45-degree field of view; 1932 by 1932 pixels: 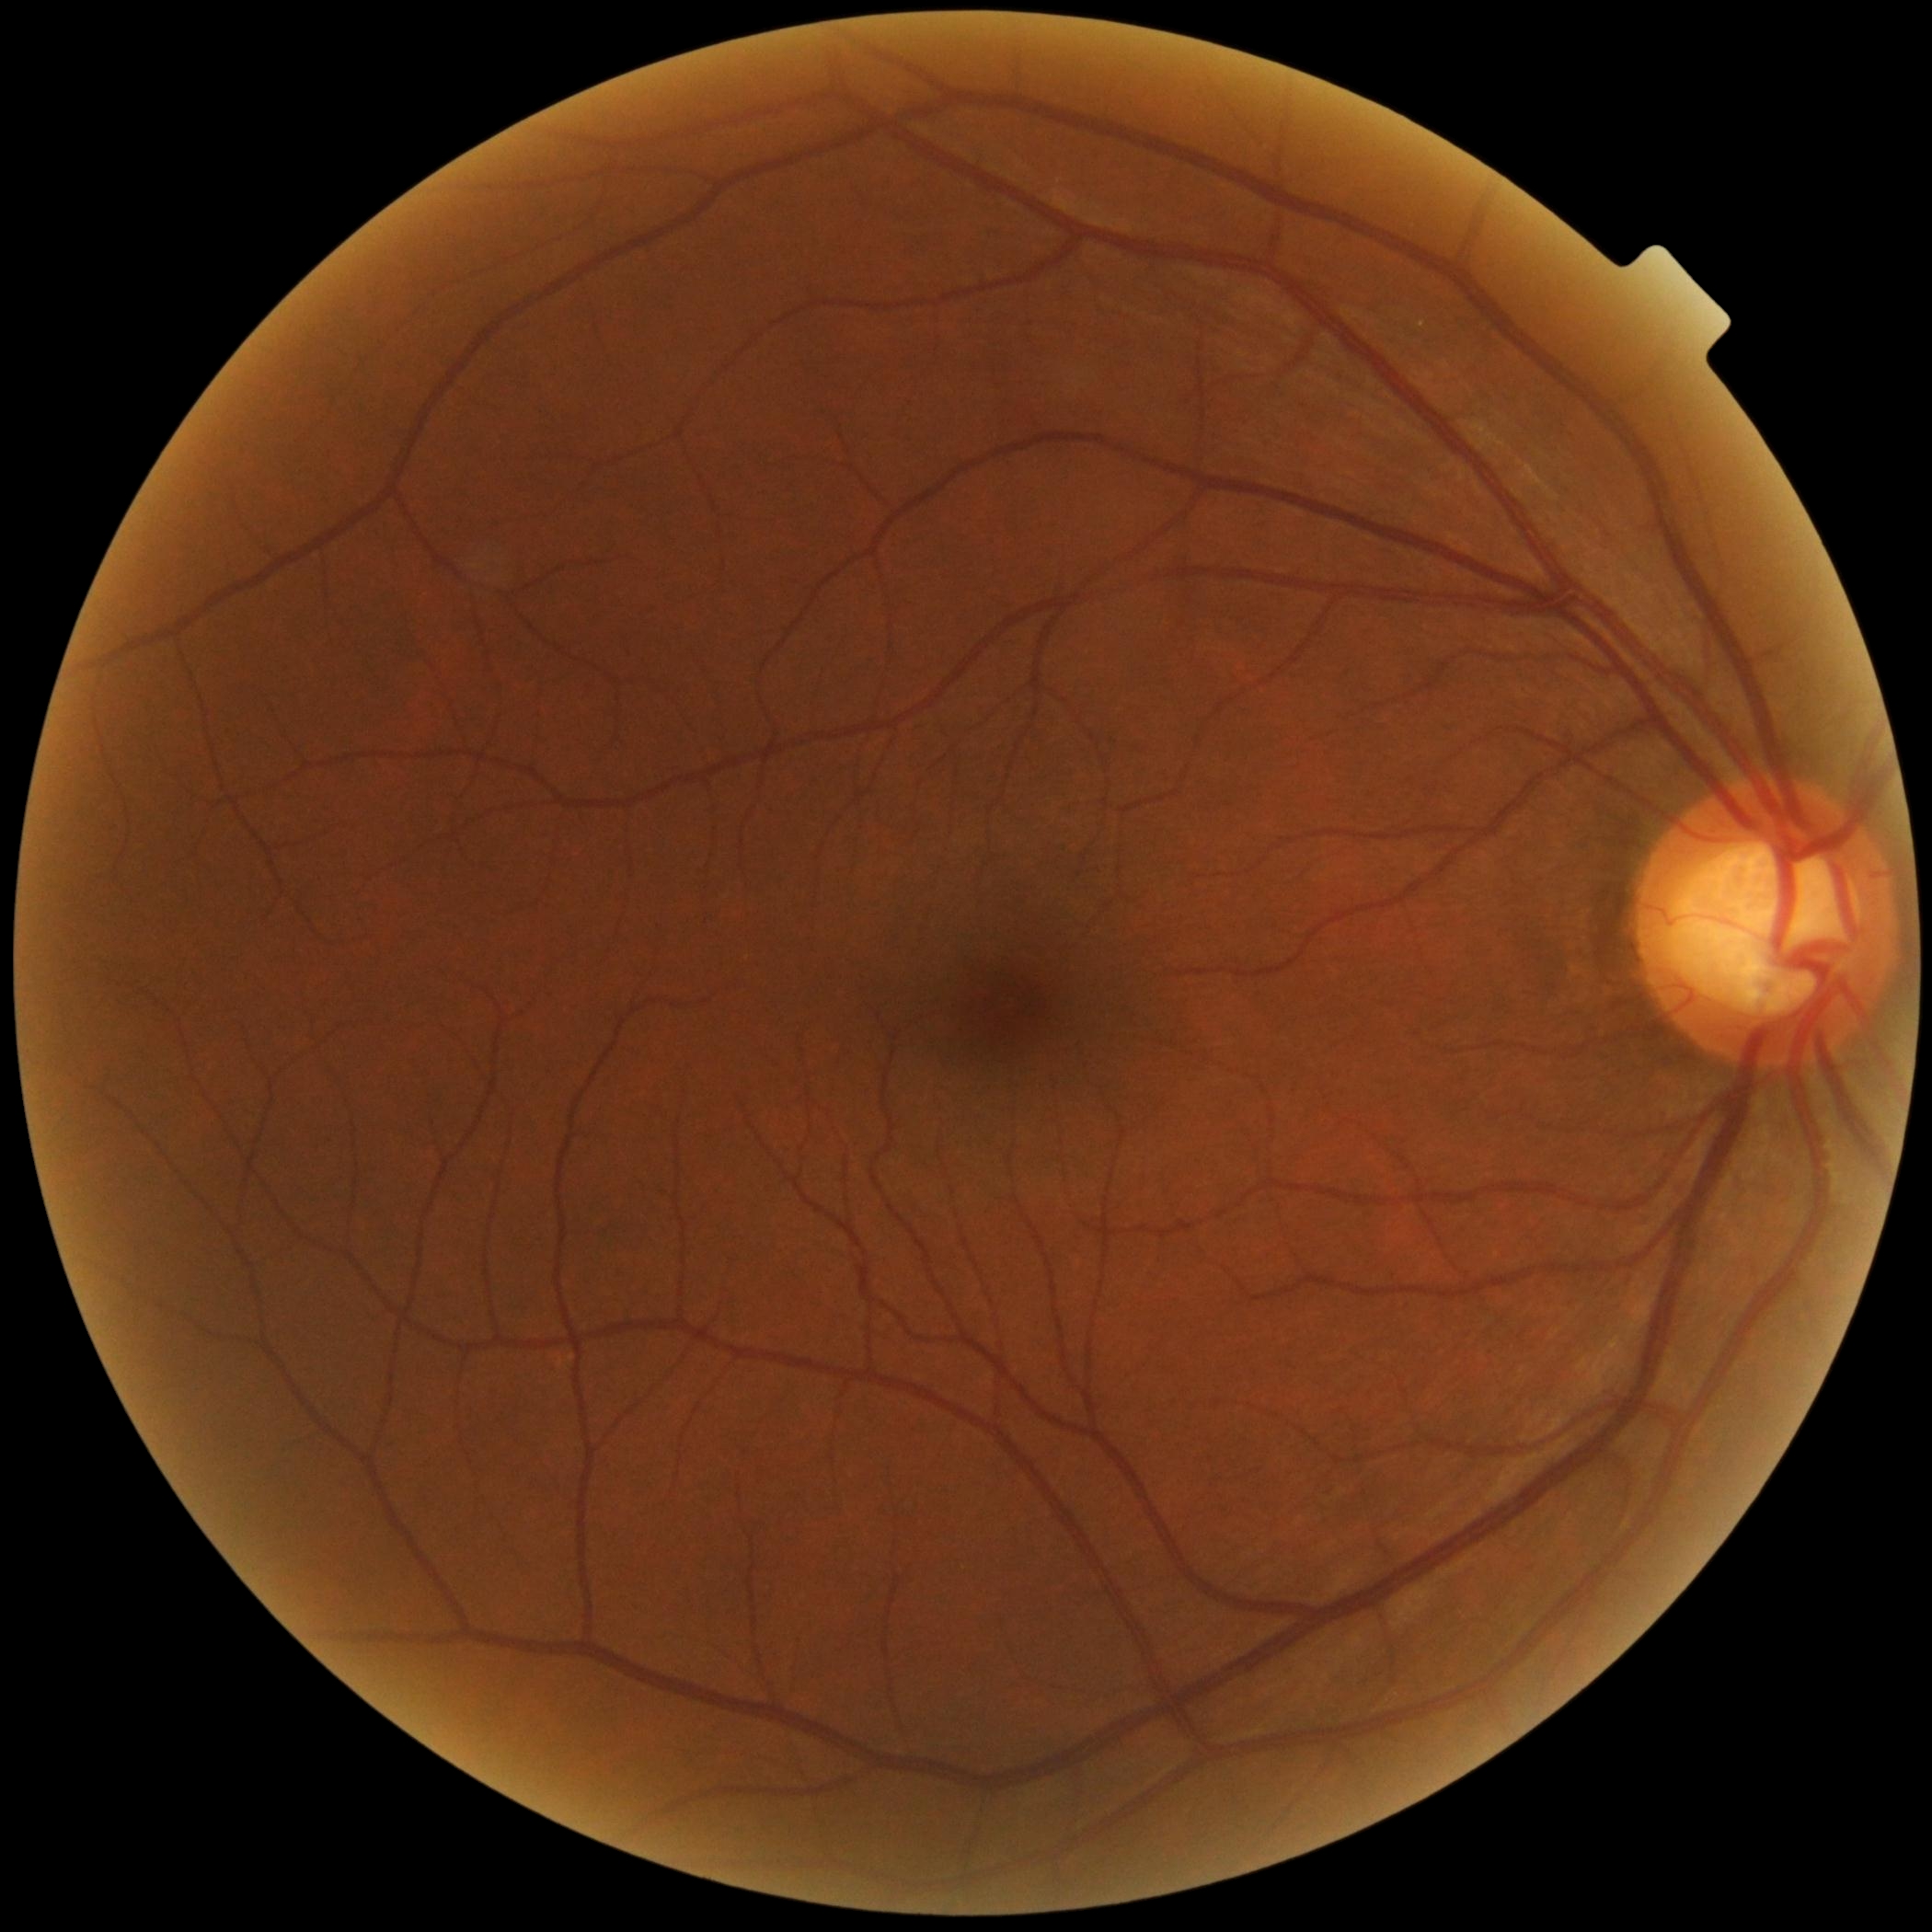   dr_grade: 0/4
  dr_impression: negative for DR